Acquired with a NIDEK AFC-230 · 848x848 · modified Davis grading
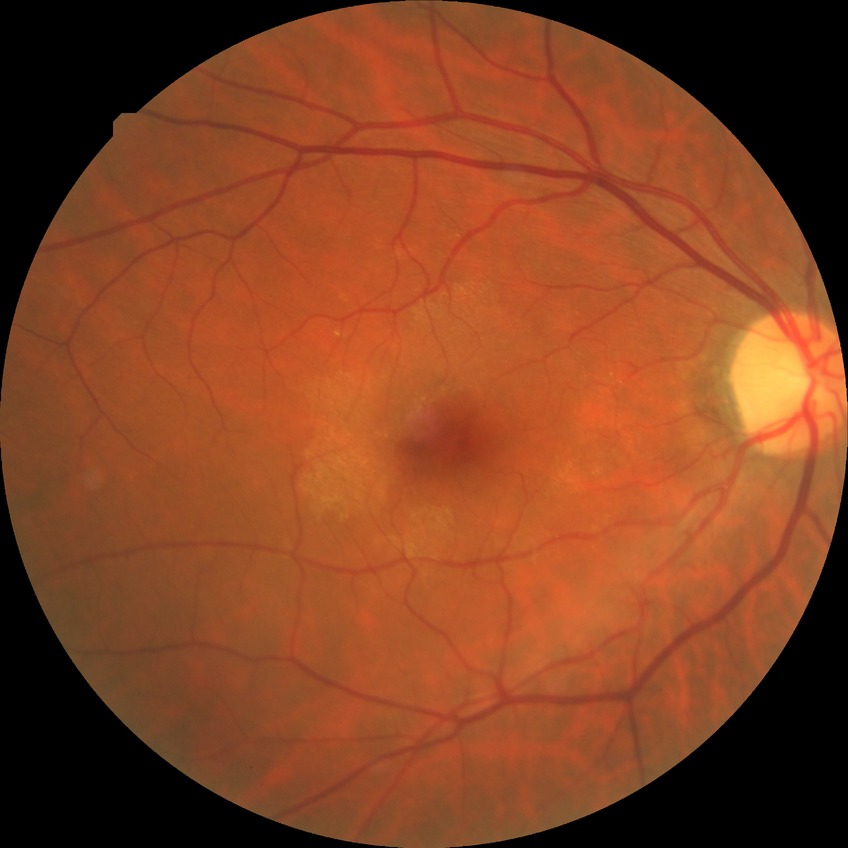

Davis grade is NDR.